Infant wide-field retinal image
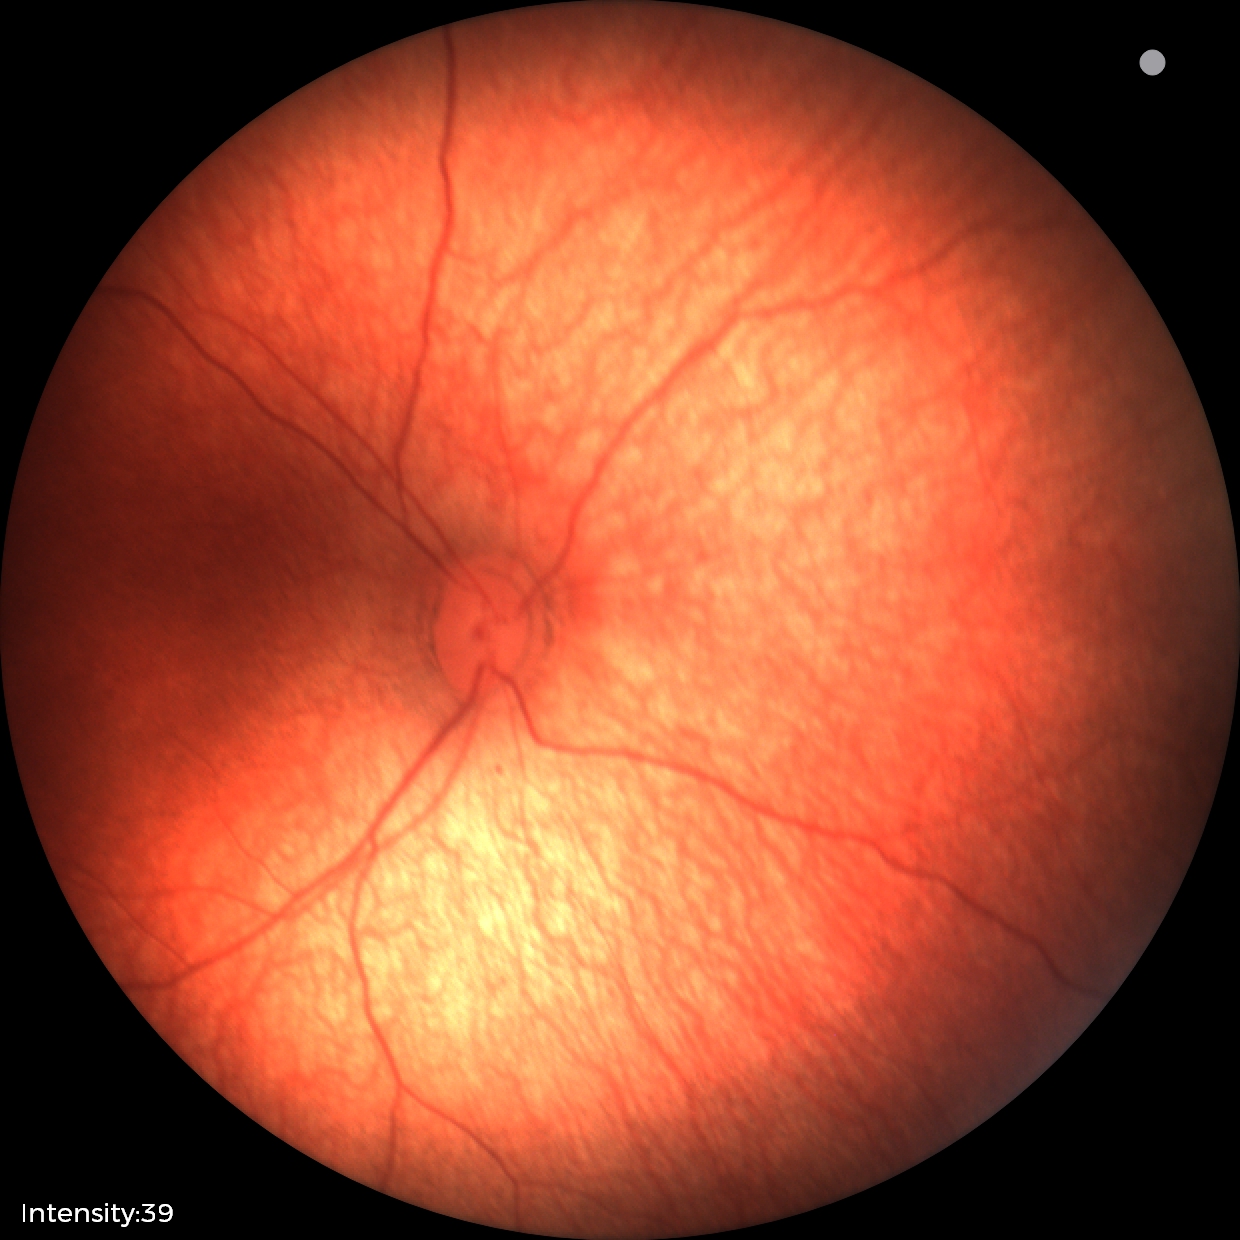
Diagnosis: physiological.